Nonmydriatic: 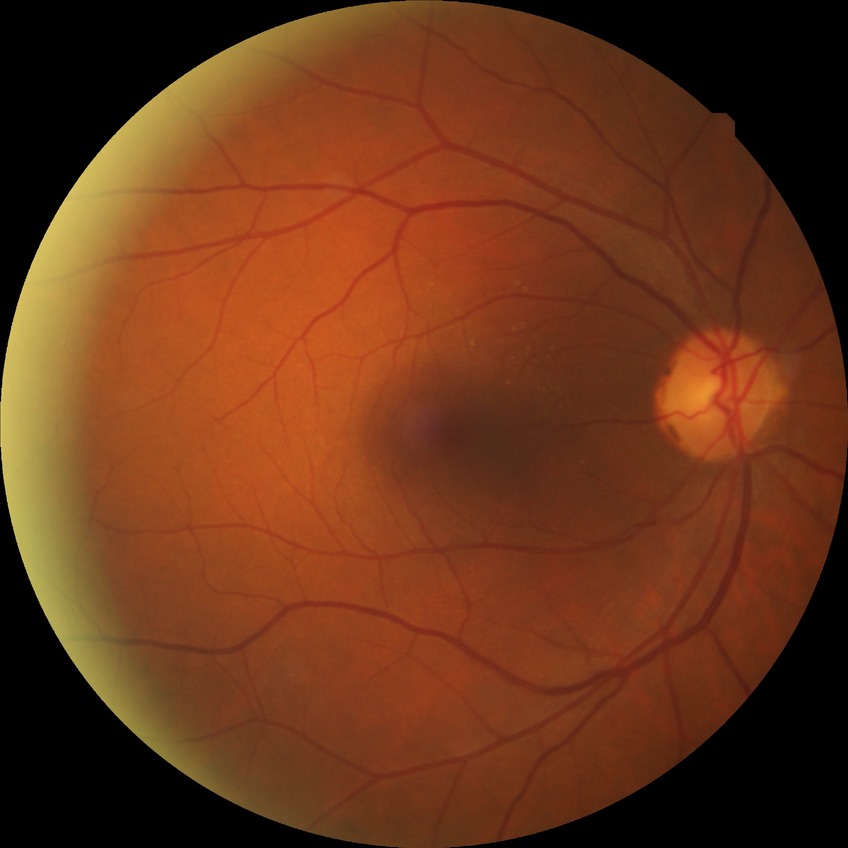 DR is NDR.